1932 by 1916 pixels · 45-degree field of view: 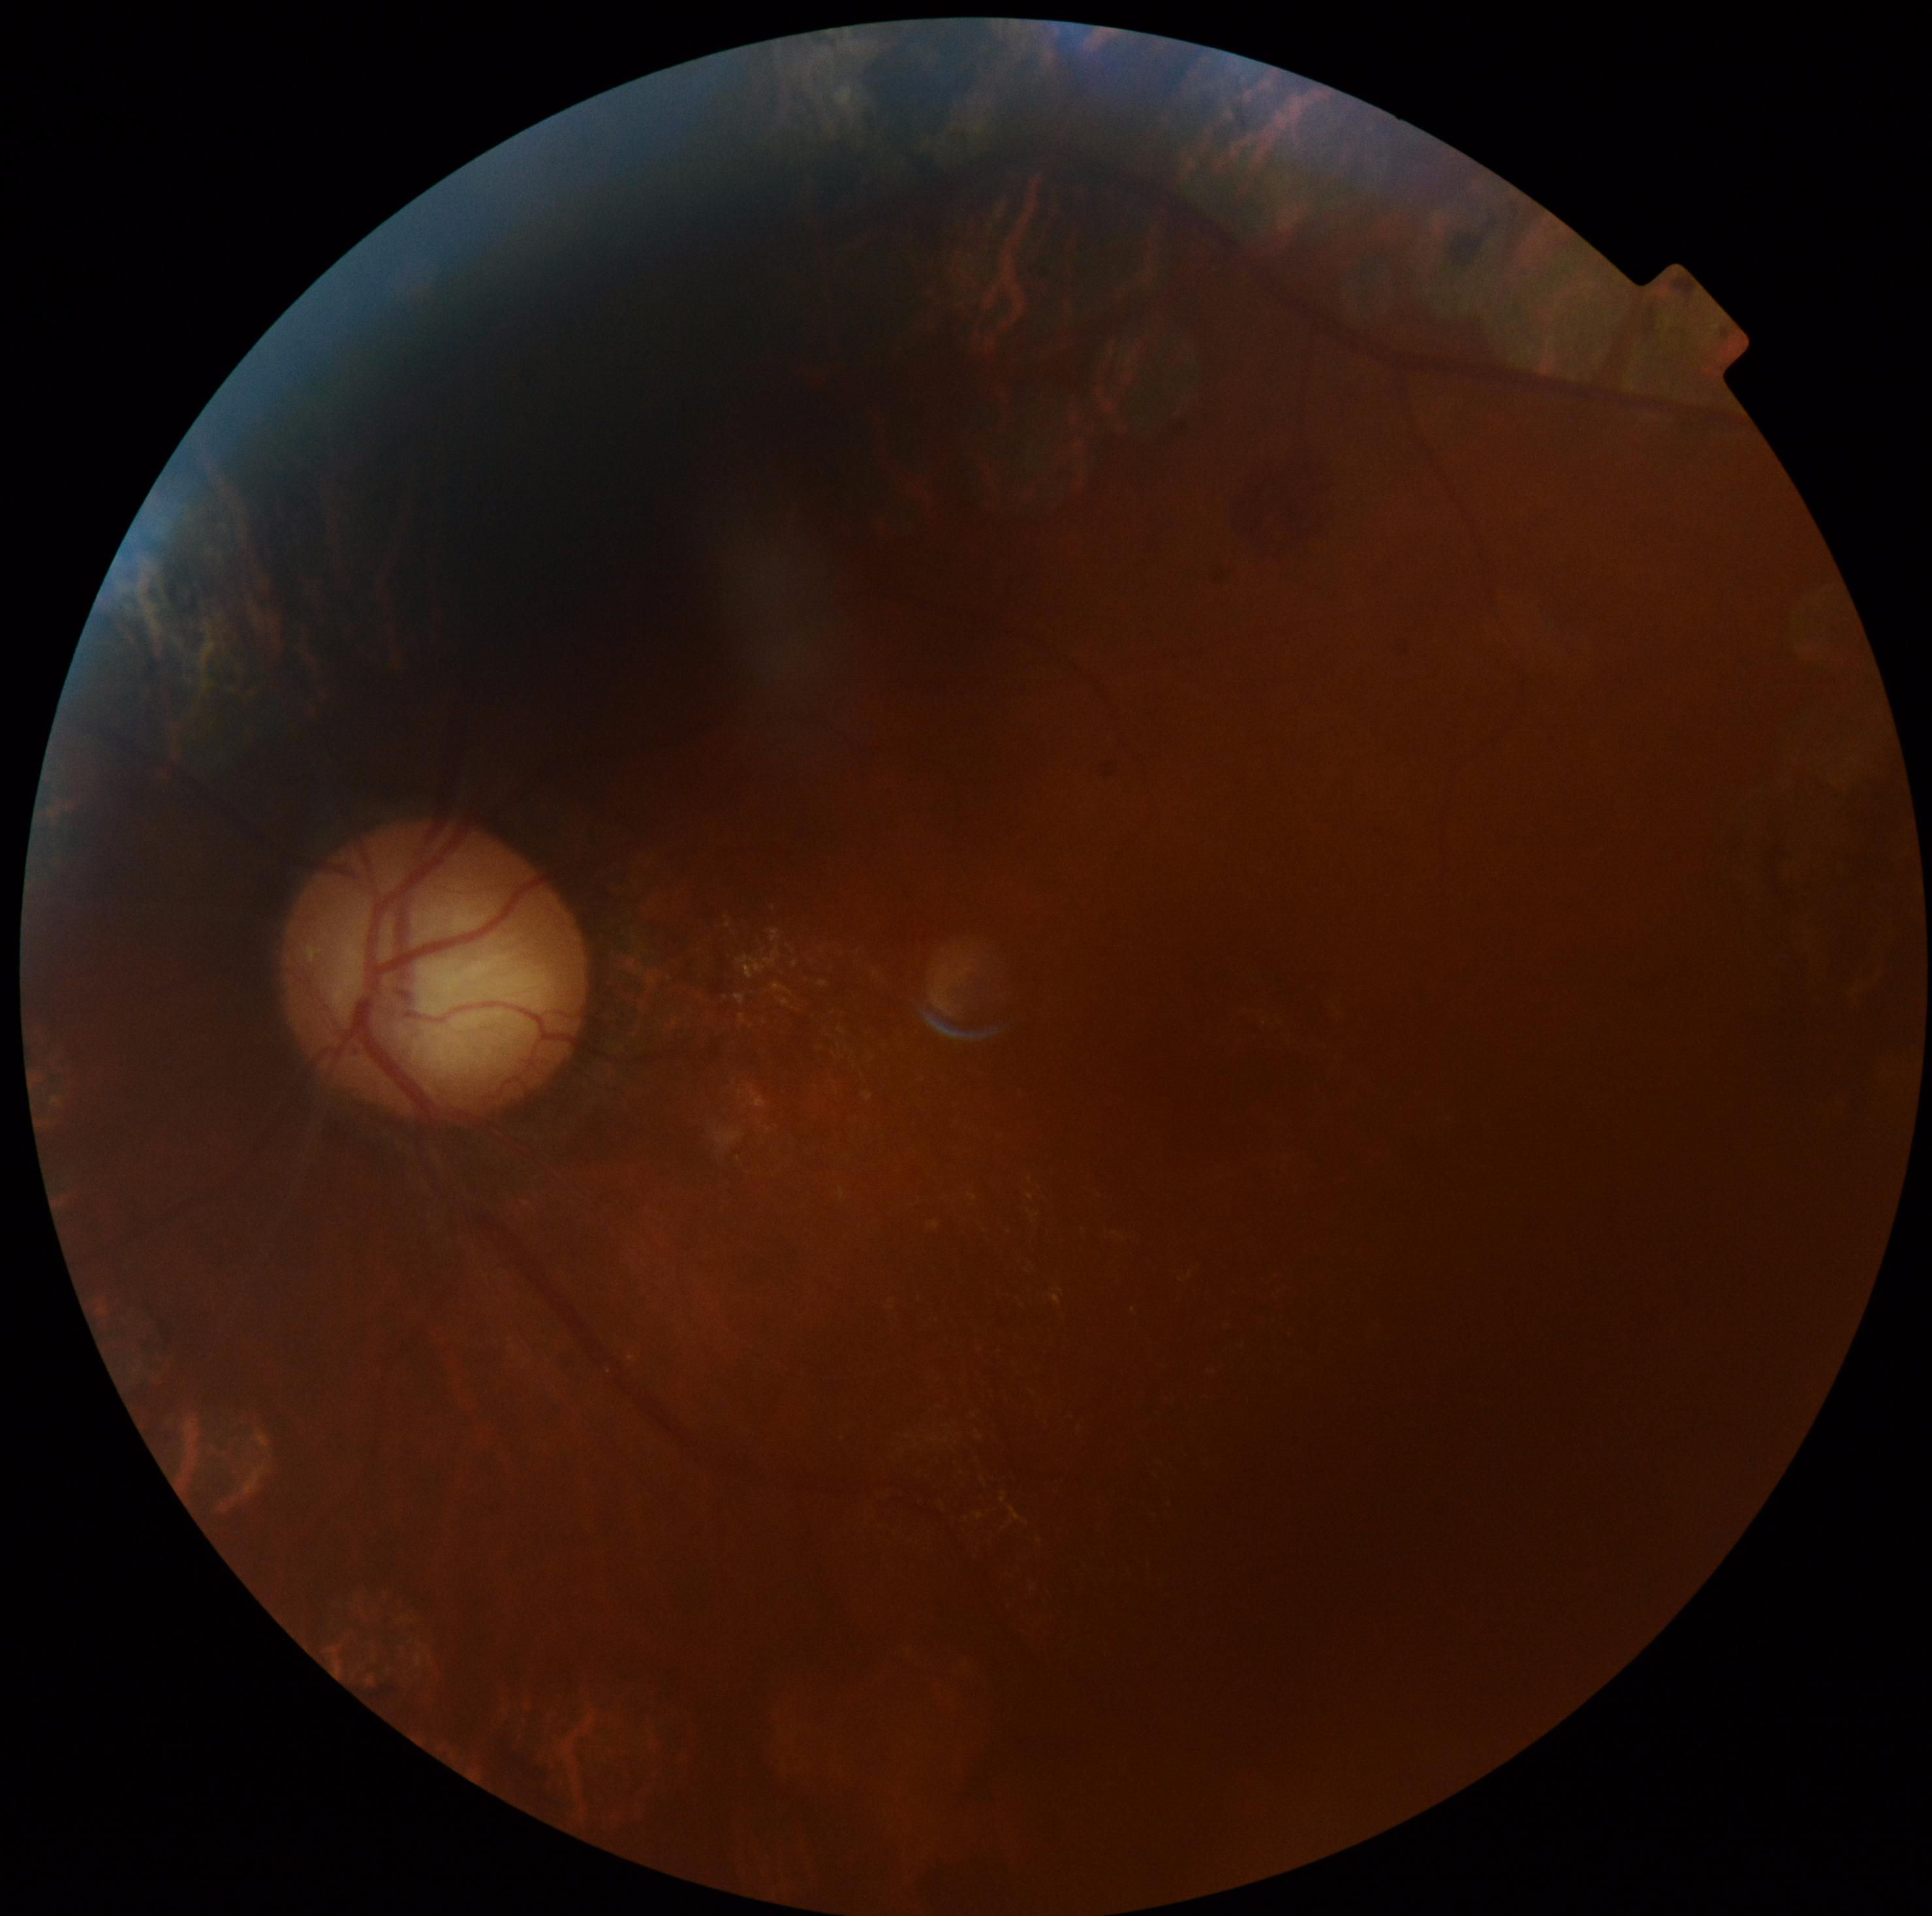
retinopathy: moderate non-proliferative diabetic retinopathy (grade 2).